Ultra-widefield fundus mosaic: 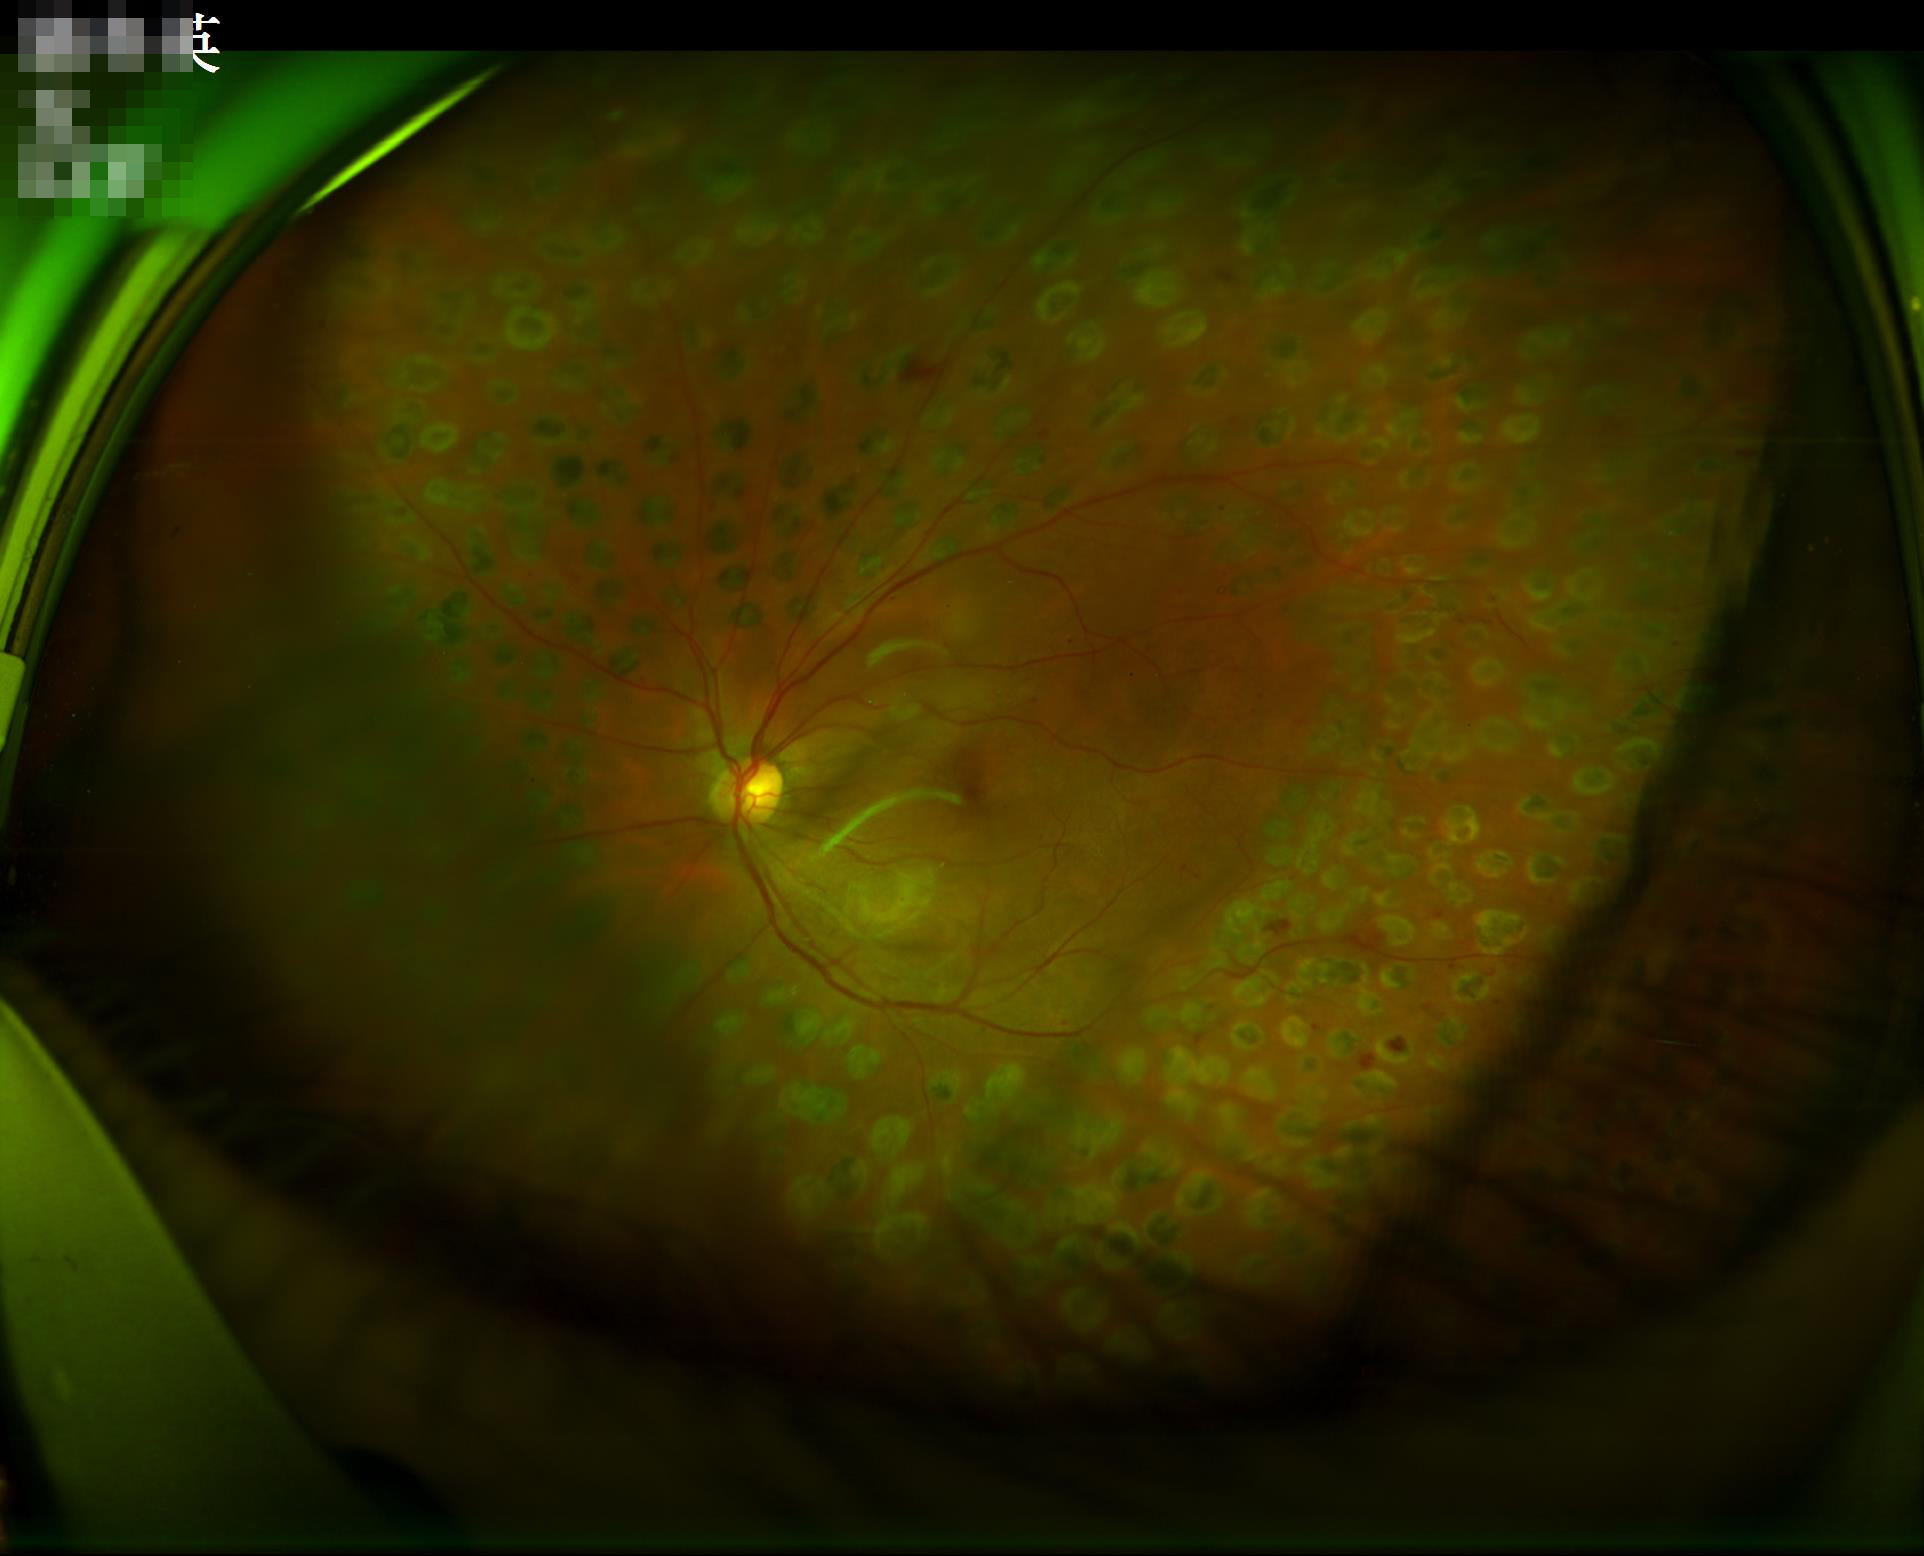 Adequate contrast for distinguishing structures.
Acceptable image quality.
The image is clear.
Illumination is uneven.